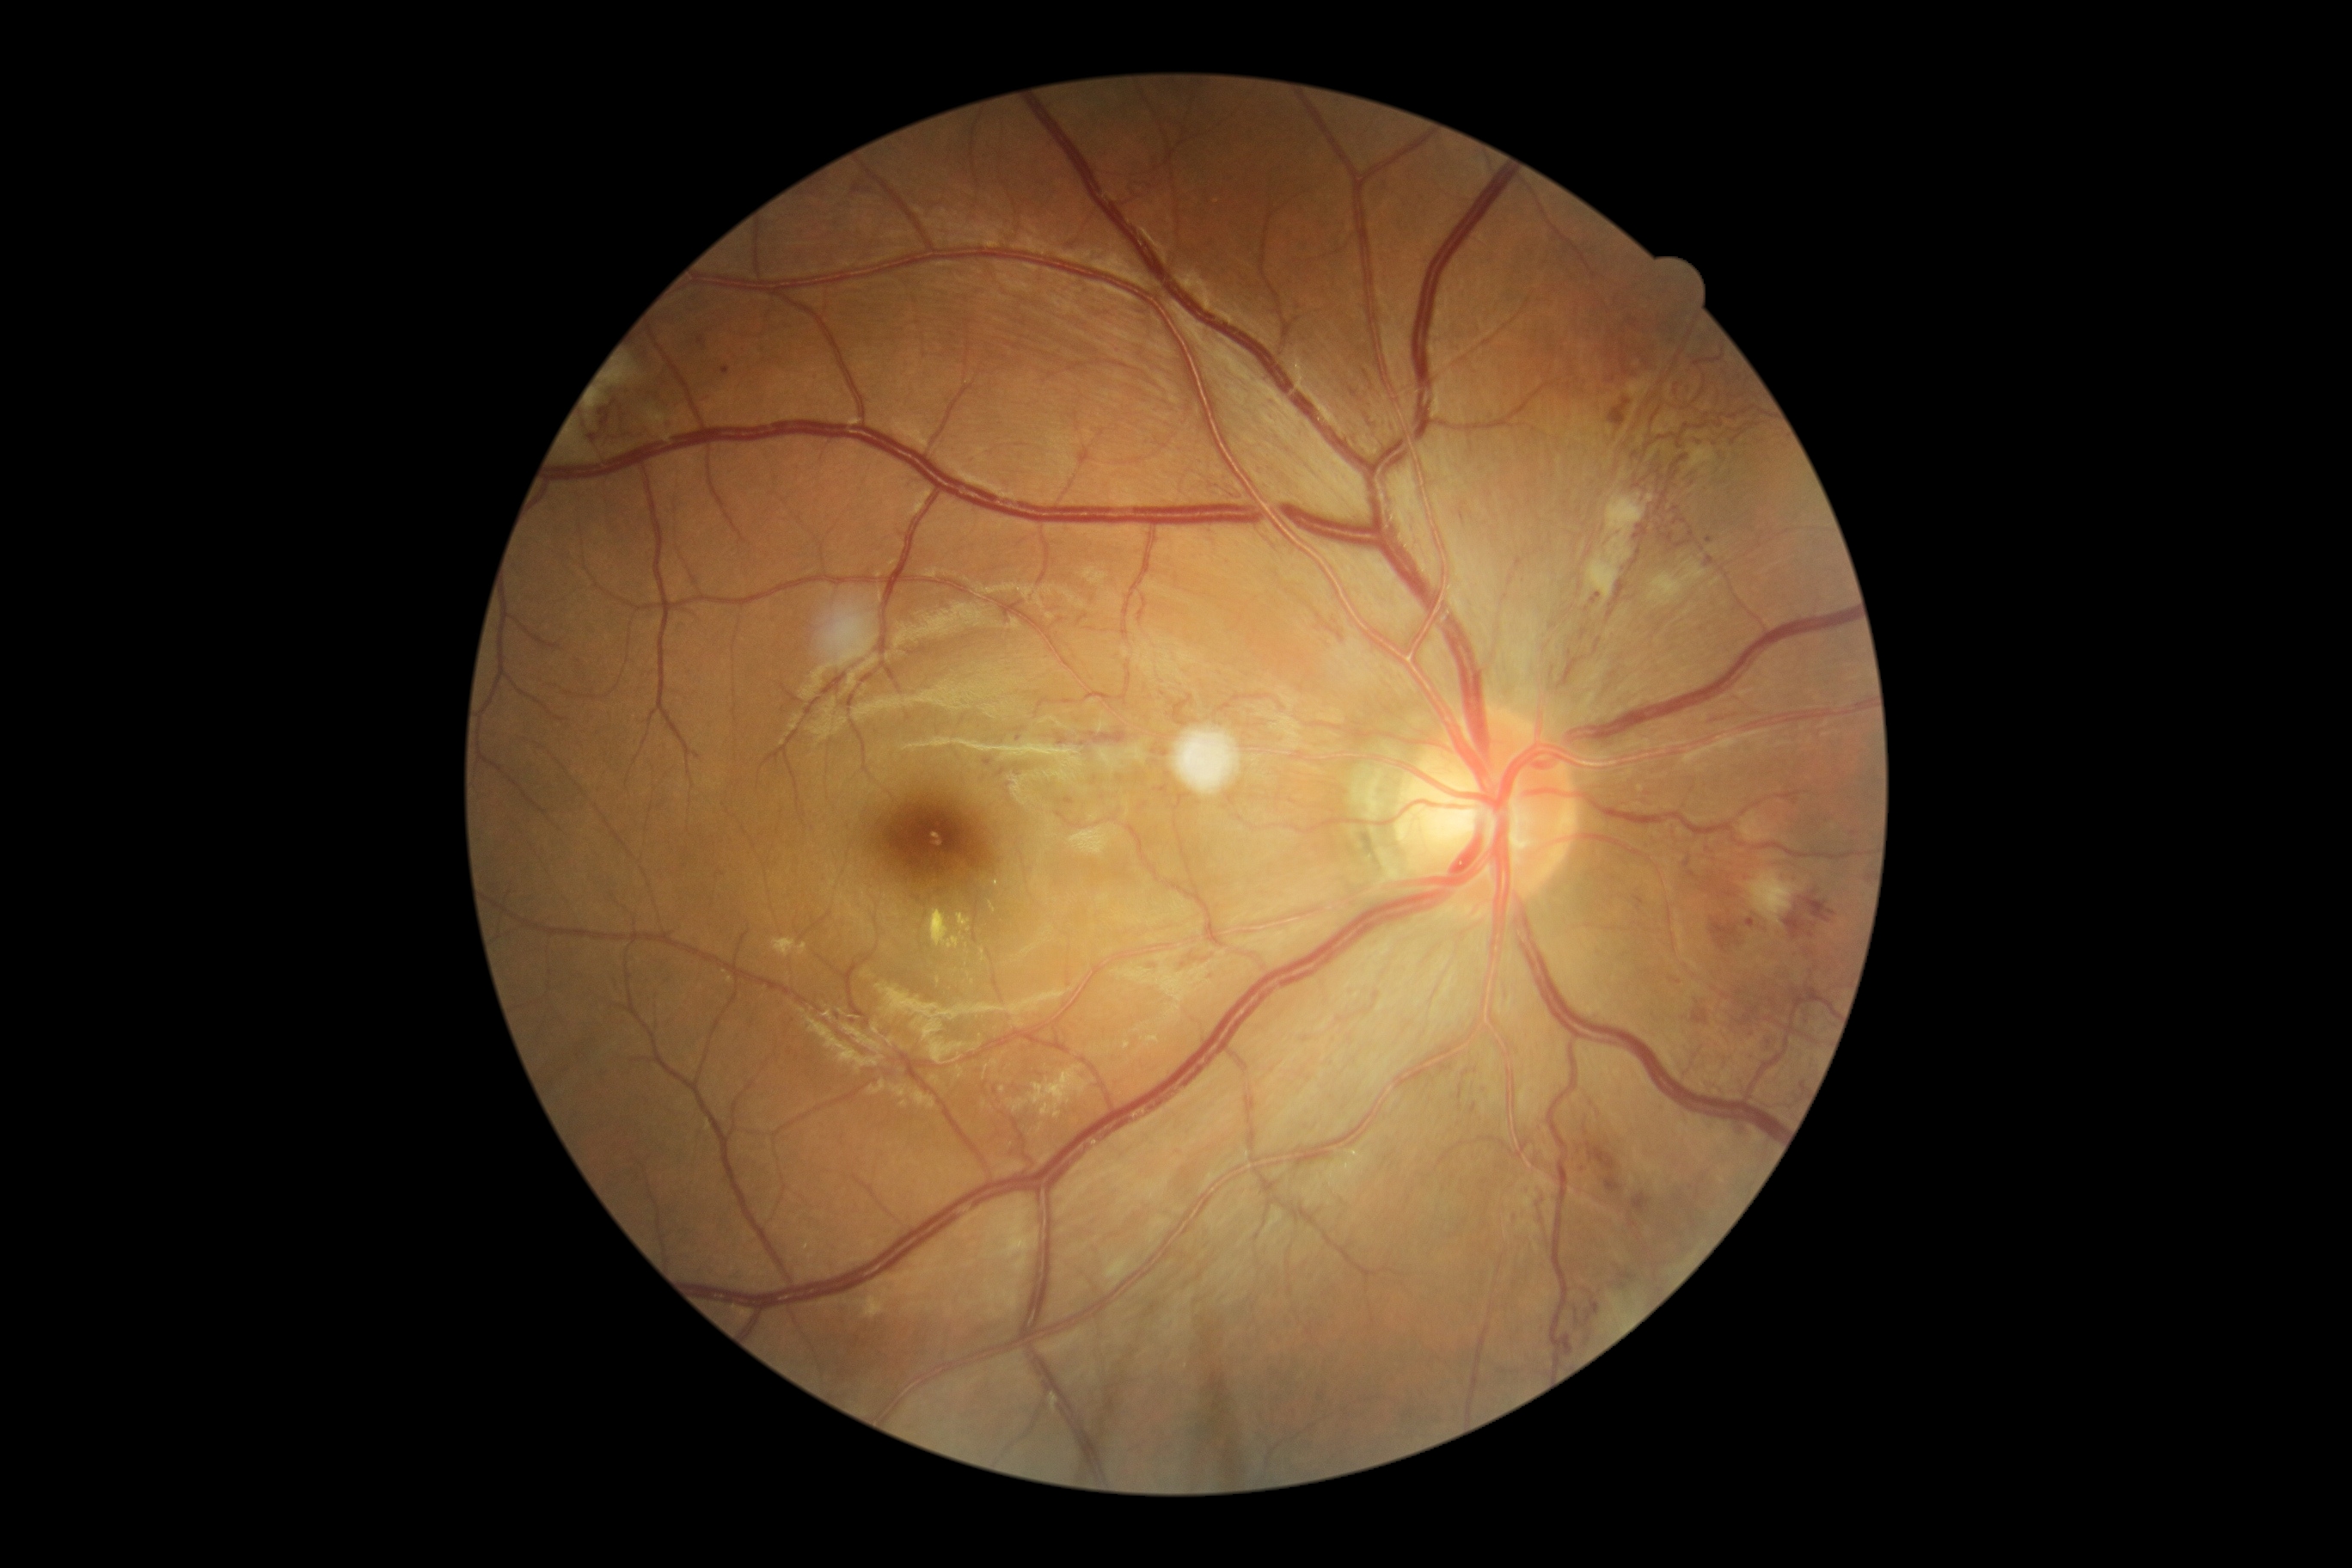 Retinopathy grade: 4/4
A subset of detected lesions:
hard exudates: {"left": 957, "top": 914, "right": 972, "bottom": 933}, {"left": 1142, "top": 1039, "right": 1153, "bottom": 1044}, {"left": 981, "top": 950, "right": 986, "bottom": 962}, {"left": 1008, "top": 1074, "right": 1065, "bottom": 1115}, {"left": 928, "top": 910, "right": 960, "bottom": 948}, {"left": 989, "top": 903, "right": 996, "bottom": 912}, {"left": 1124, "top": 1043, "right": 1132, "bottom": 1050}
Additional small hard exudates near pt(938, 981), pt(962, 936)
soft exudates: {"left": 1650, "top": 560, "right": 1710, "bottom": 606}, {"left": 568, "top": 436, "right": 599, "bottom": 462}, {"left": 592, "top": 395, "right": 601, "bottom": 408}, {"left": 1746, "top": 869, "right": 1801, "bottom": 928}, {"left": 1588, "top": 493, "right": 1653, "bottom": 603}, {"left": 608, "top": 358, "right": 637, "bottom": 386}
hemorrhages (partial): {"left": 1139, "top": 802, "right": 1148, "bottom": 811}, {"left": 1206, "top": 969, "right": 1218, "bottom": 976}, {"left": 1632, "top": 893, "right": 1645, "bottom": 907}, {"left": 1670, "top": 977, "right": 1681, "bottom": 984}, {"left": 1632, "top": 1196, "right": 1651, "bottom": 1215}, {"left": 1785, "top": 912, "right": 1815, "bottom": 940}, {"left": 1710, "top": 917, "right": 1741, "bottom": 953}, {"left": 1608, "top": 398, "right": 1631, "bottom": 429}, {"left": 1586, "top": 1142, "right": 1620, "bottom": 1194}, {"left": 1629, "top": 319, "right": 1638, "bottom": 328}, {"left": 1579, "top": 628, "right": 1588, "bottom": 642}, {"left": 1693, "top": 1008, "right": 1708, "bottom": 1026}, {"left": 1682, "top": 852, "right": 1701, "bottom": 881}, {"left": 1737, "top": 1007, "right": 1760, "bottom": 1027}, {"left": 1459, "top": 1086, "right": 1462, "bottom": 1099}, {"left": 1156, "top": 785, "right": 1172, "bottom": 799}, {"left": 1153, "top": 747, "right": 1170, "bottom": 757}
Additional small hemorrhages near pt(1084, 744)
microaneurysms: {"left": 697, "top": 336, "right": 707, "bottom": 348}, {"left": 984, "top": 759, "right": 993, "bottom": 766}, {"left": 1705, "top": 556, "right": 1715, "bottom": 567}, {"left": 721, "top": 367, "right": 732, "bottom": 376}, {"left": 996, "top": 769, "right": 1007, "bottom": 778}, {"left": 1708, "top": 714, "right": 1720, "bottom": 721}, {"left": 1722, "top": 706, "right": 1748, "bottom": 714}
Additional small microaneurysms near pt(1813, 926), pt(1709, 540), pt(1553, 626), pt(1019, 738)